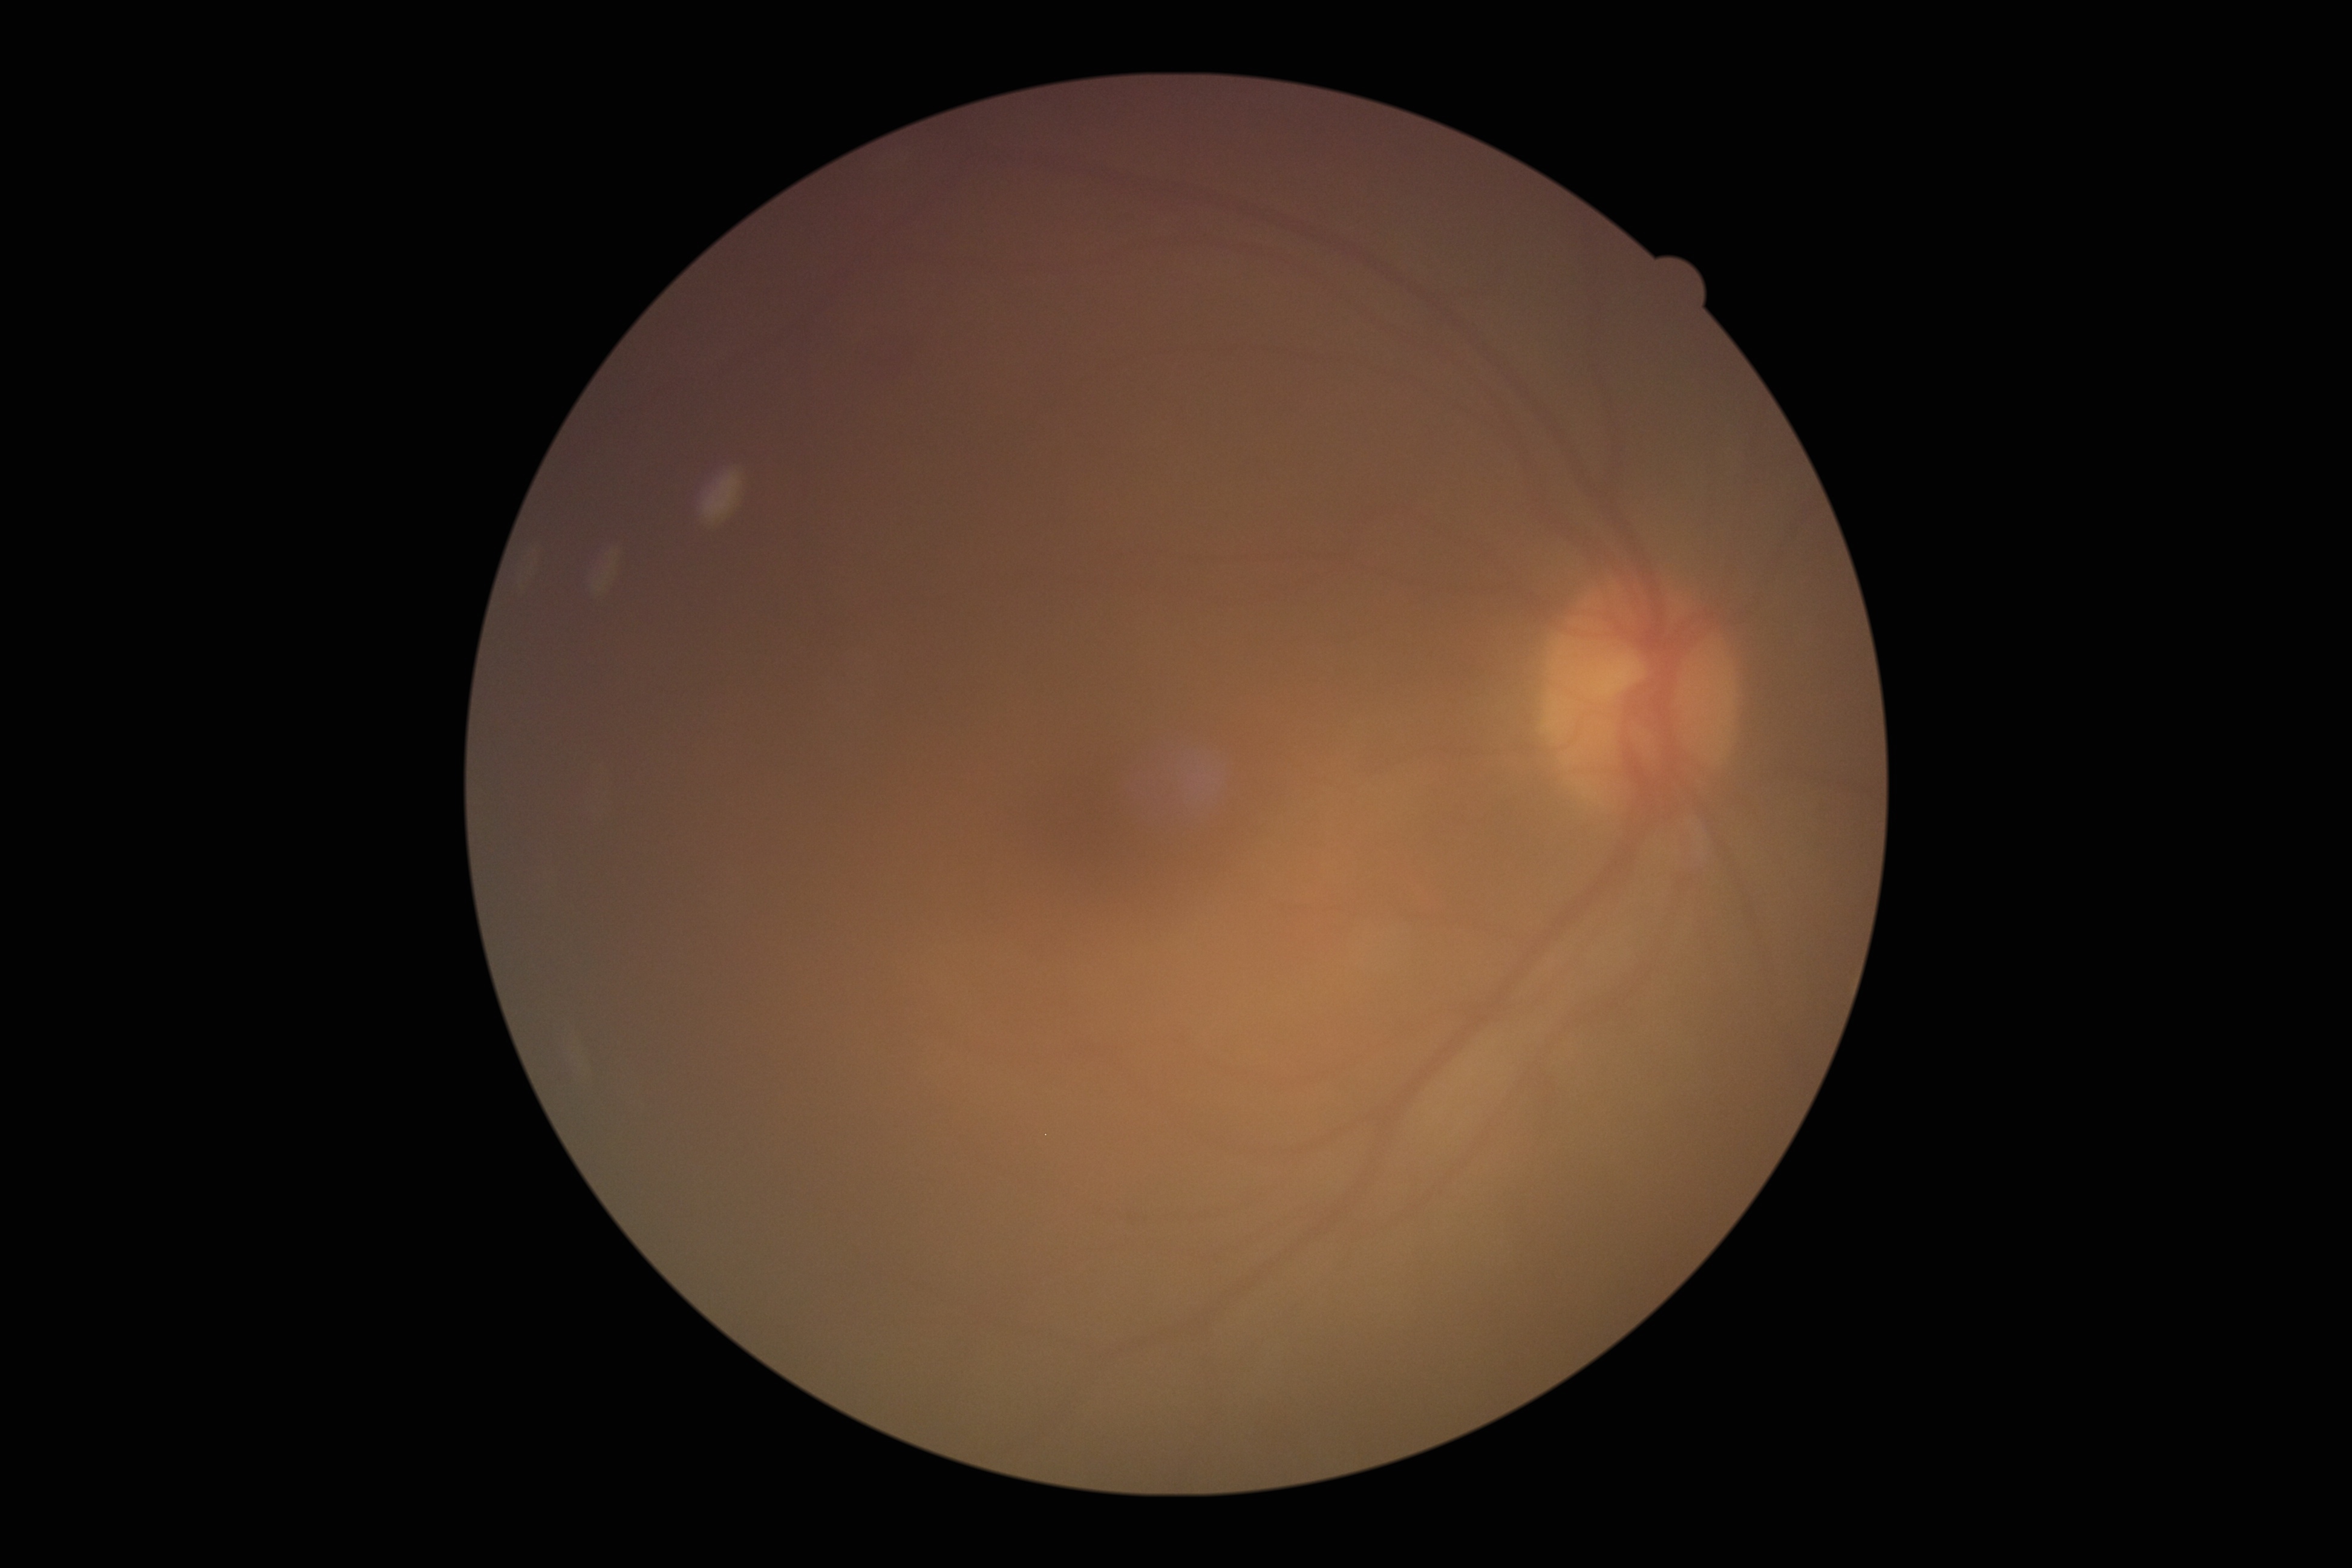 DR class: non-proliferative diabetic retinopathy.
Retinopathy grade is 2/4.